Camera: NIDEK AFC-230, posterior pole photograph.
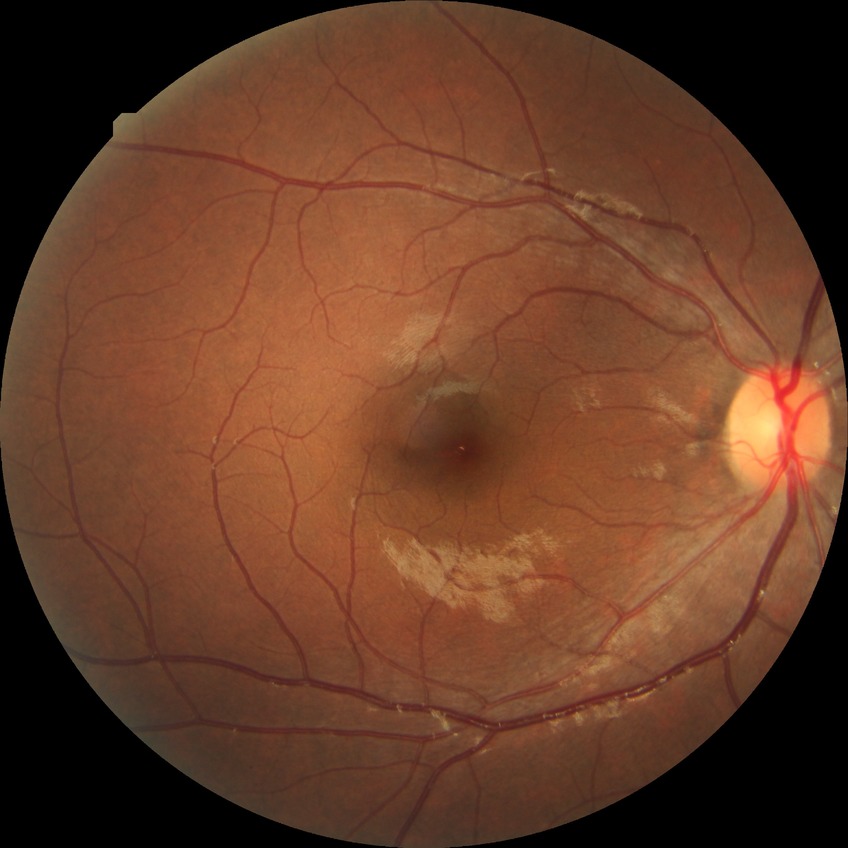
Diabetic retinopathy grade is no diabetic retinopathy.